2048 by 1536 pixels — 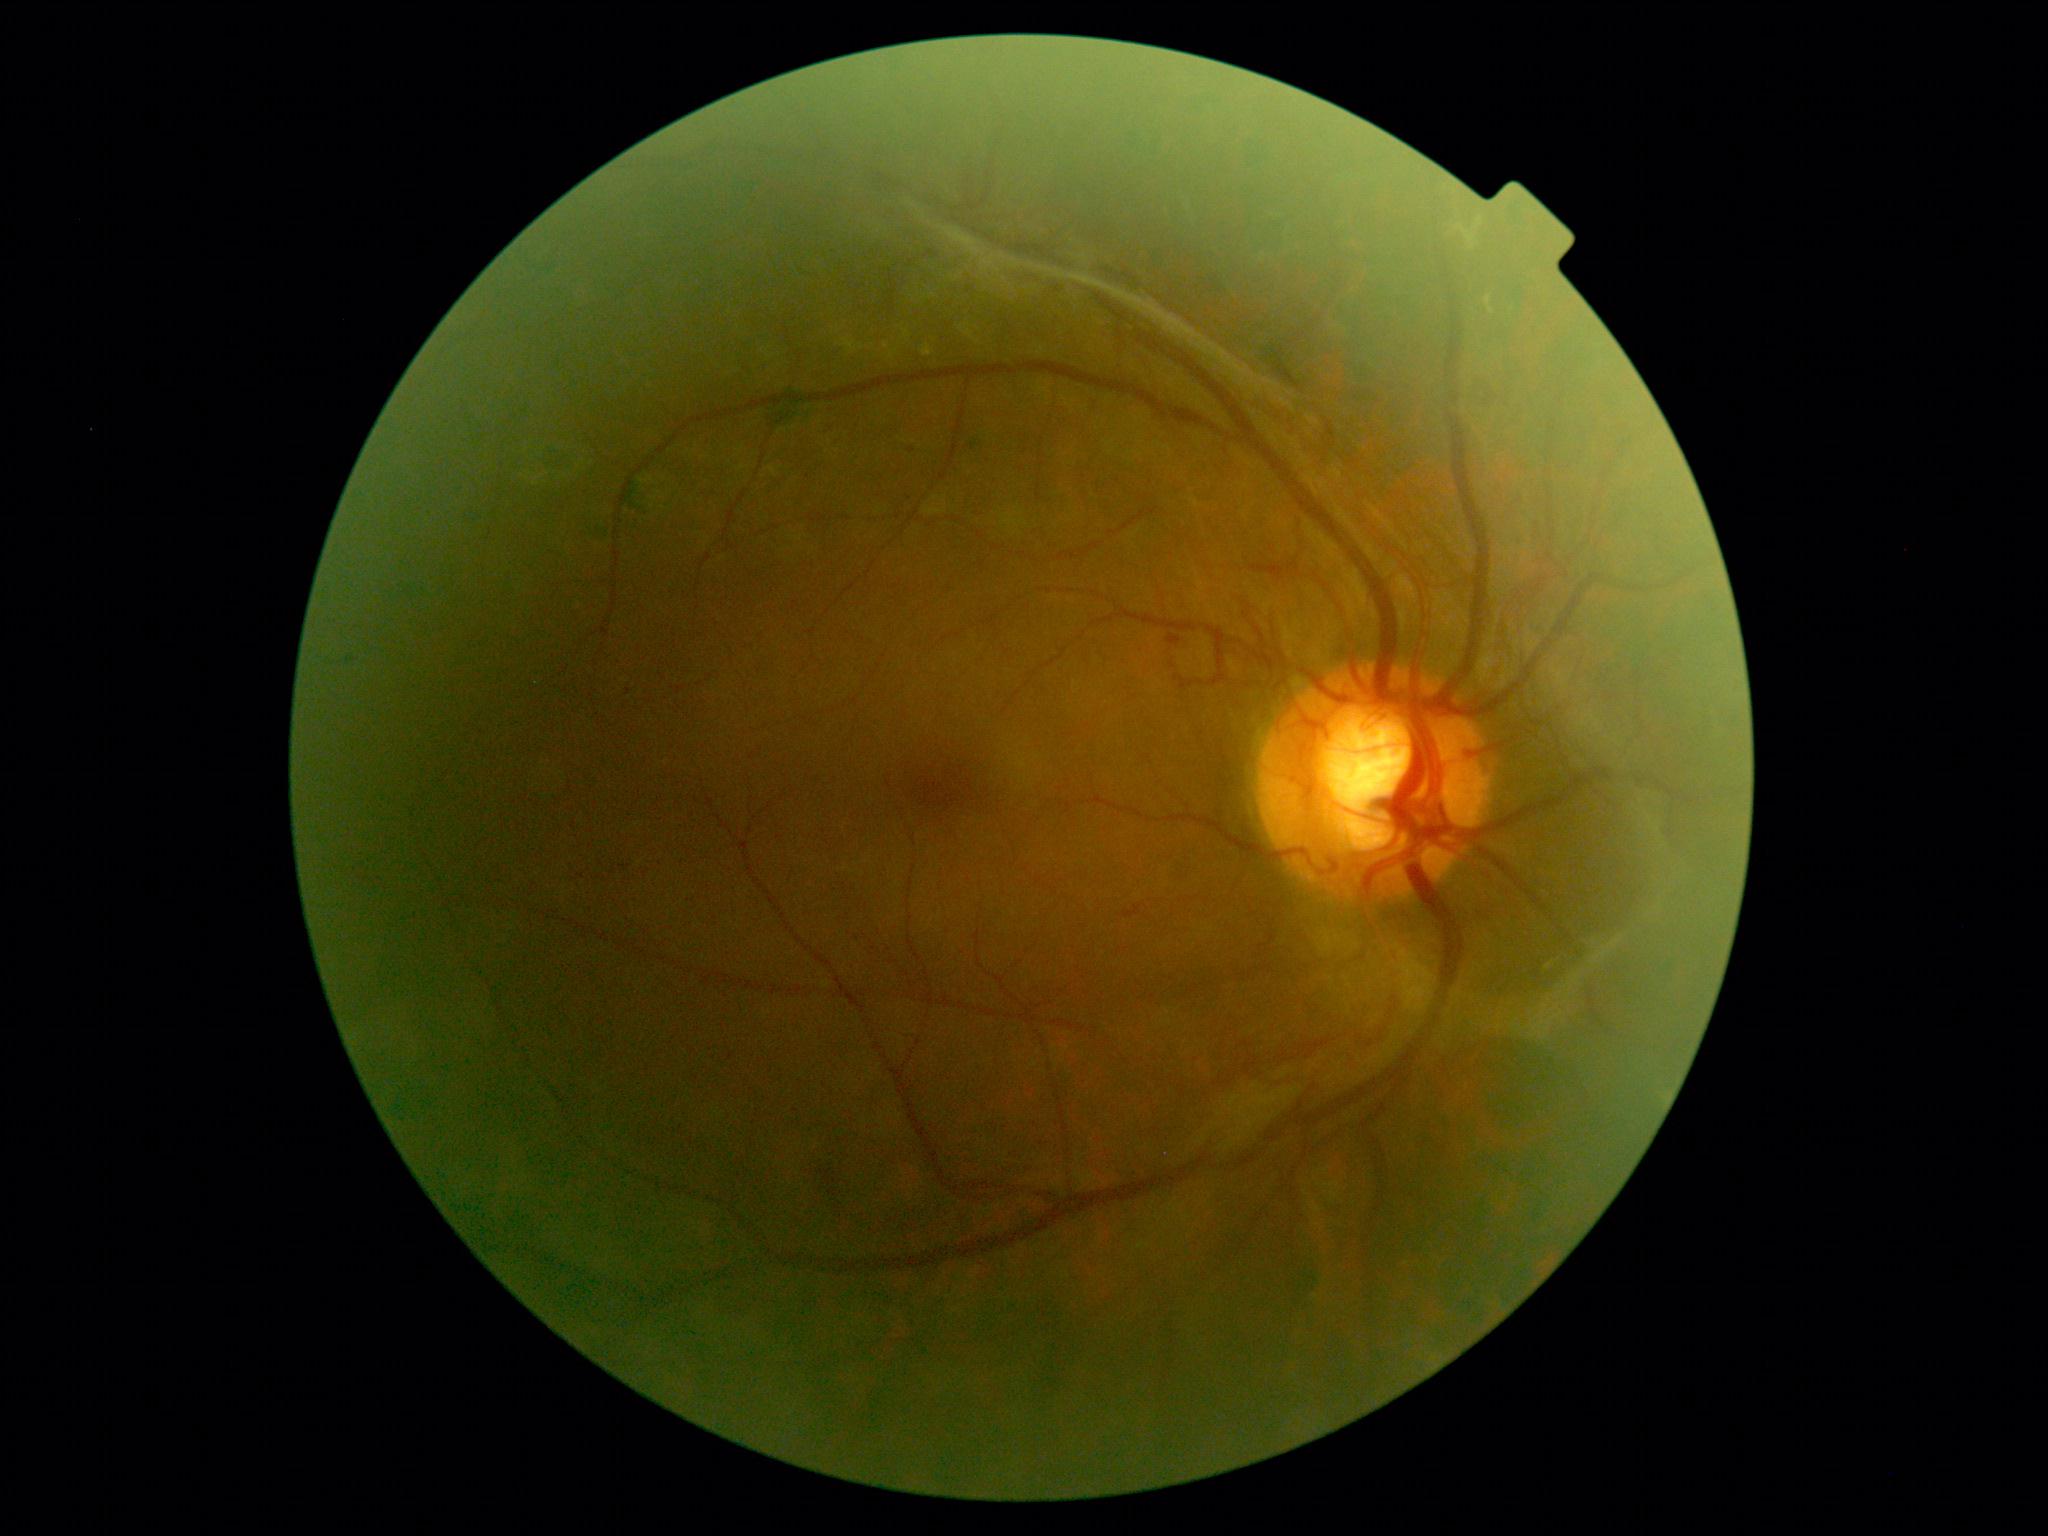
Annotations:
• diabetic retinopathy (DR): PDR (grade 4)